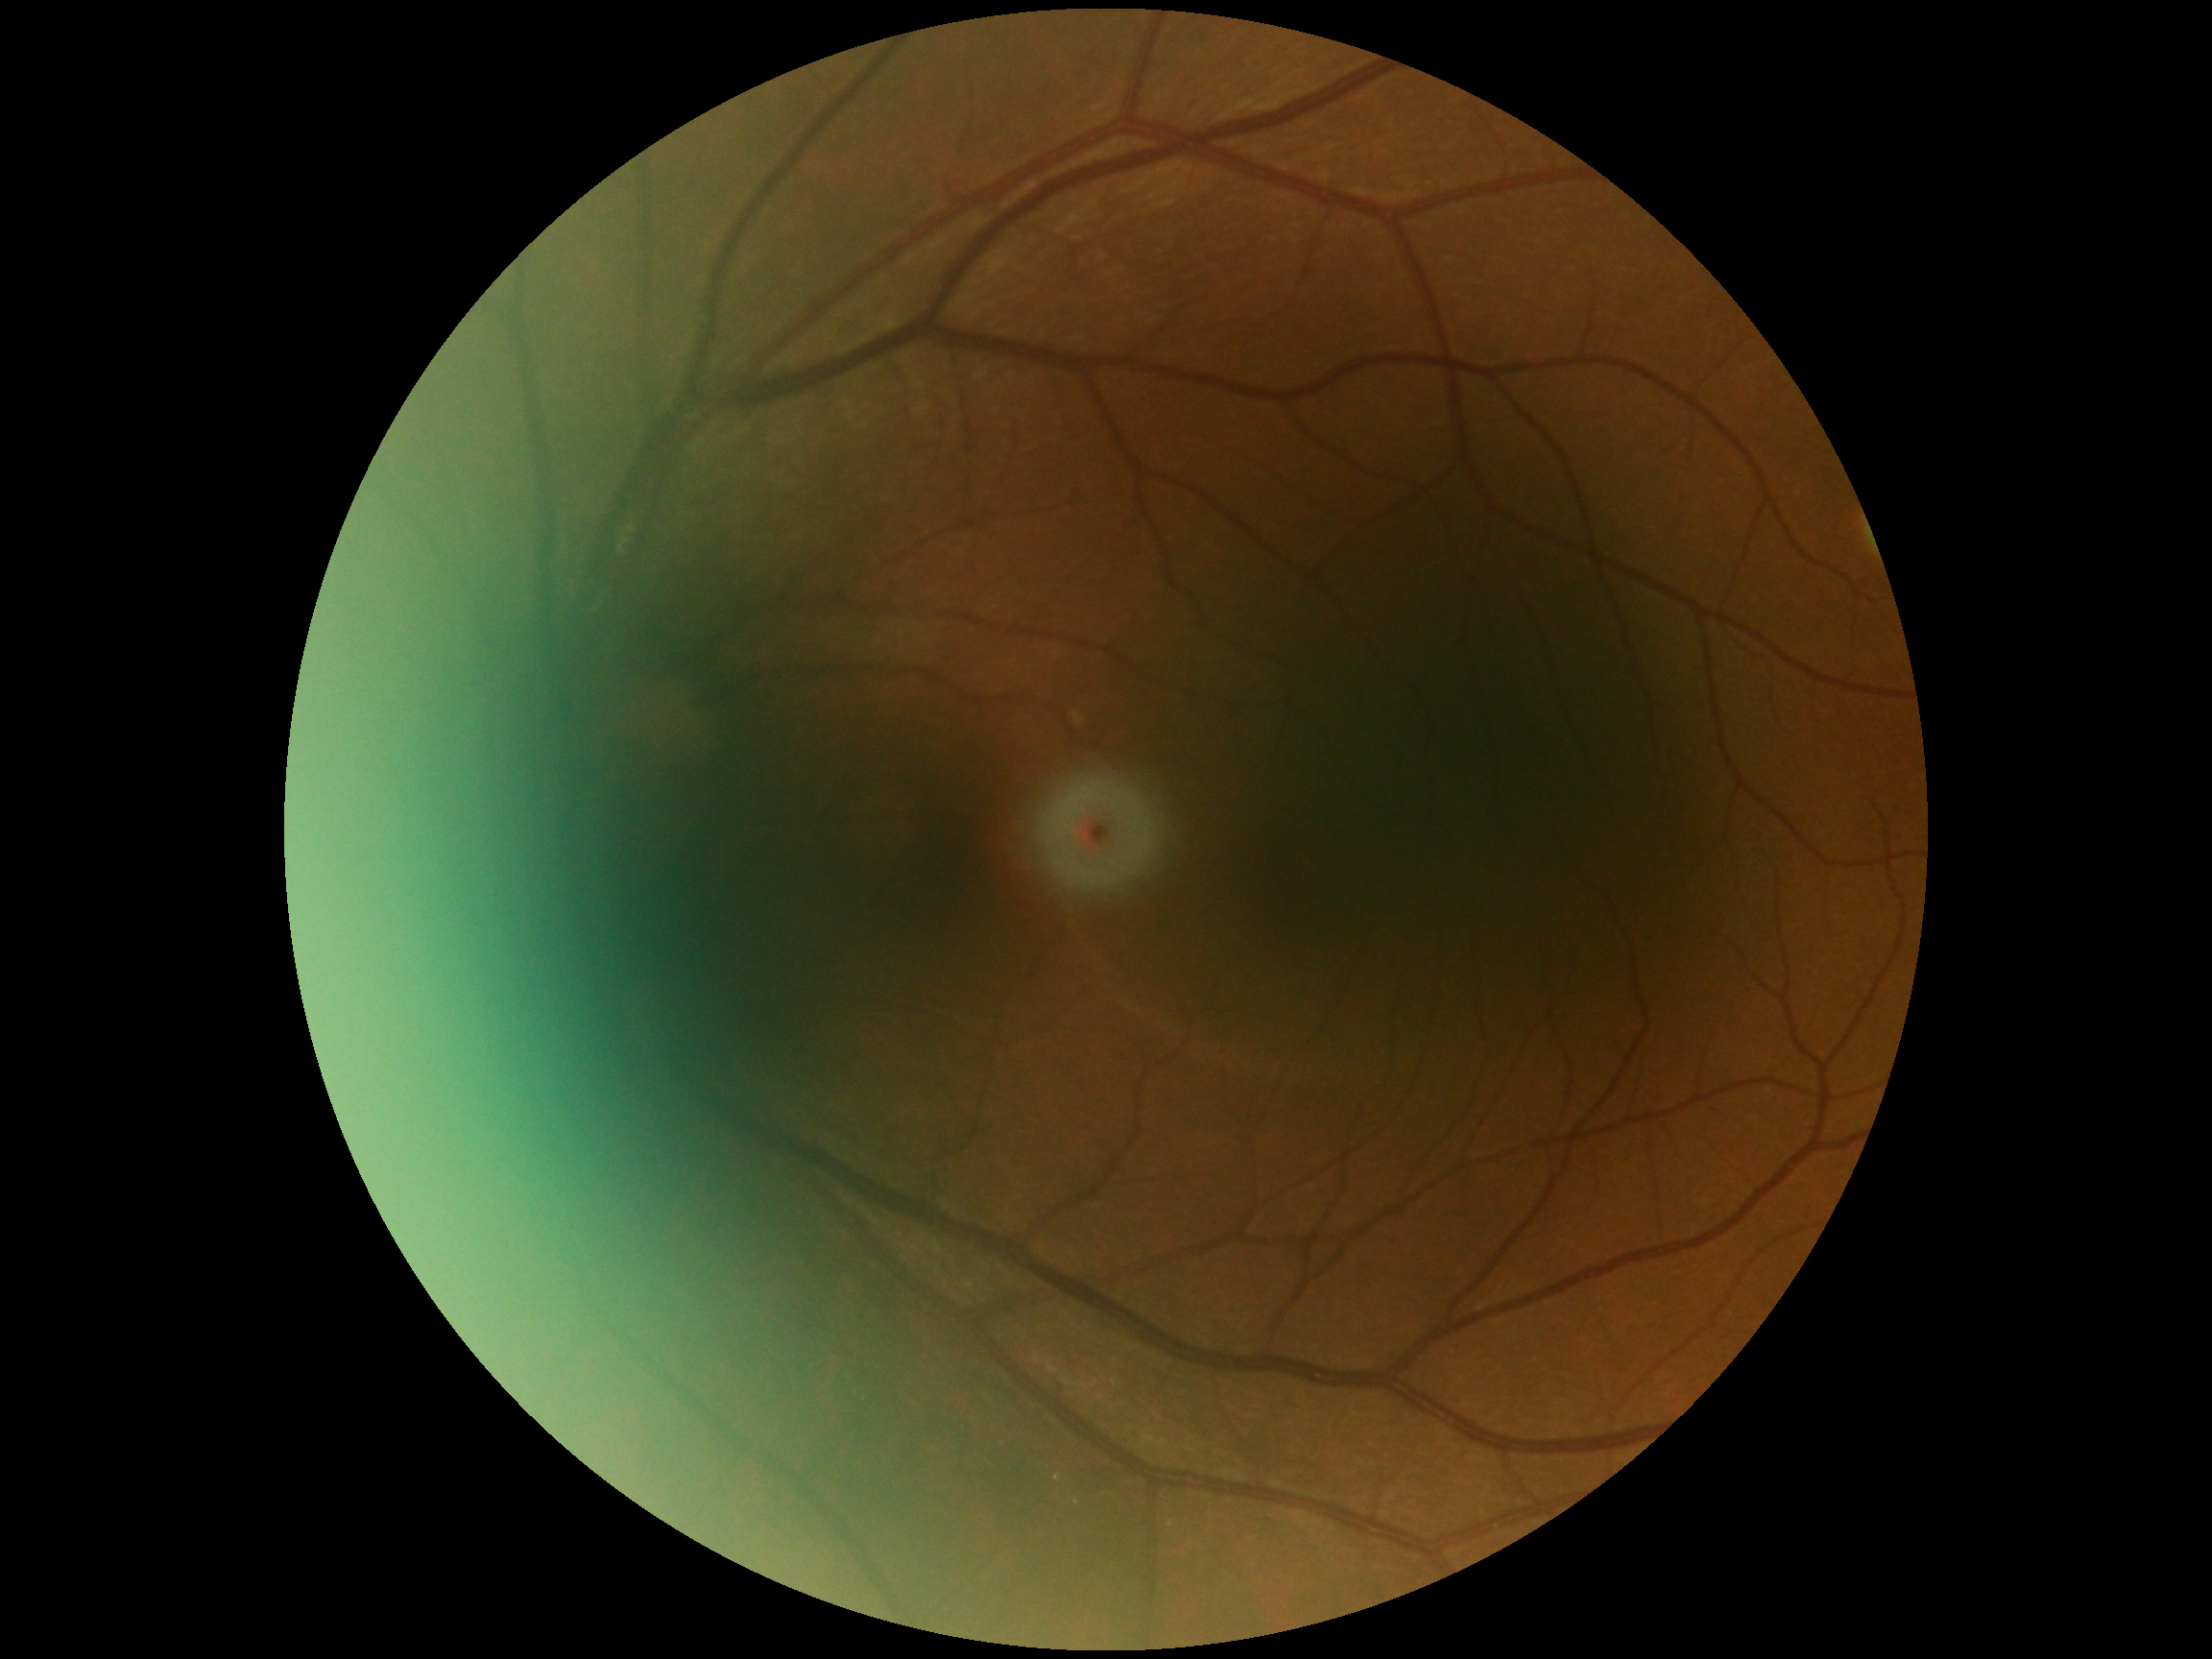 DR grade is no apparent diabetic retinopathy (0) — no visible signs of diabetic retinopathy.